NIDEK AFC-230:
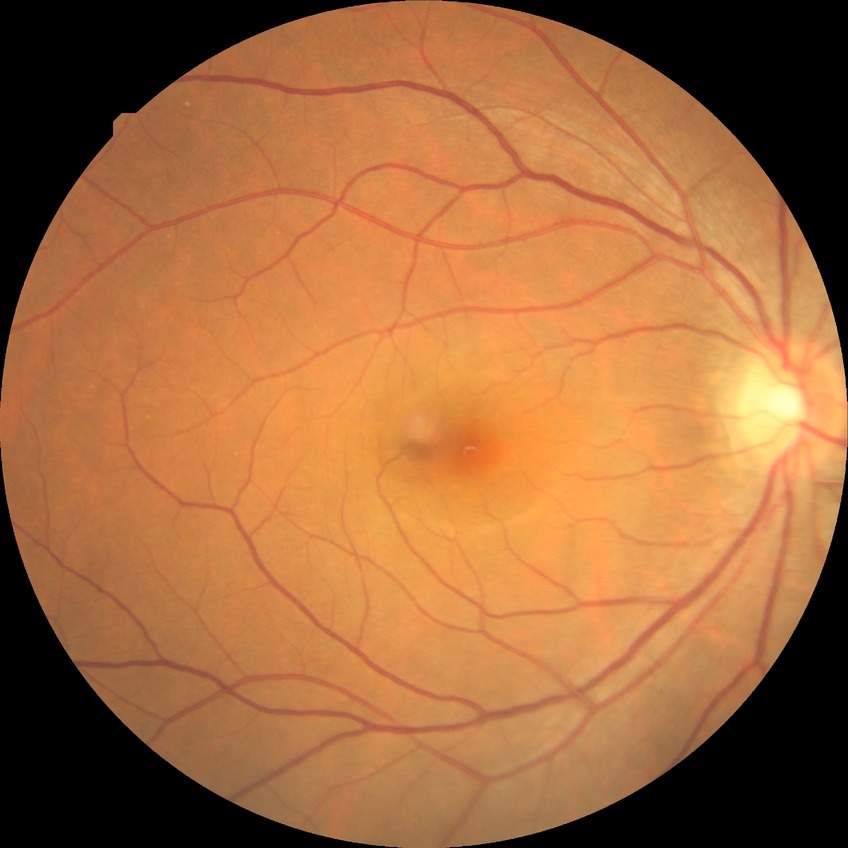 Retinopathy grade: no diabetic retinopathy.